Posterior pole color fundus photograph; modified Davis classification; NIDEK AFC-230.
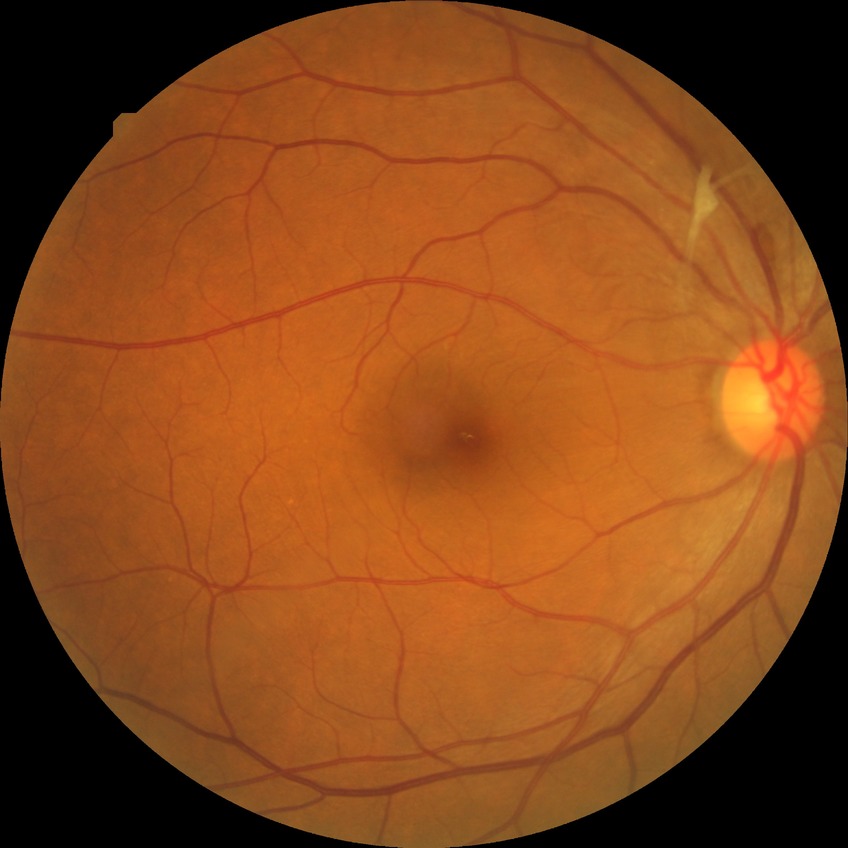
Retinopathy grade is no diabetic retinopathy.